Pediatric wide-field fundus photograph: 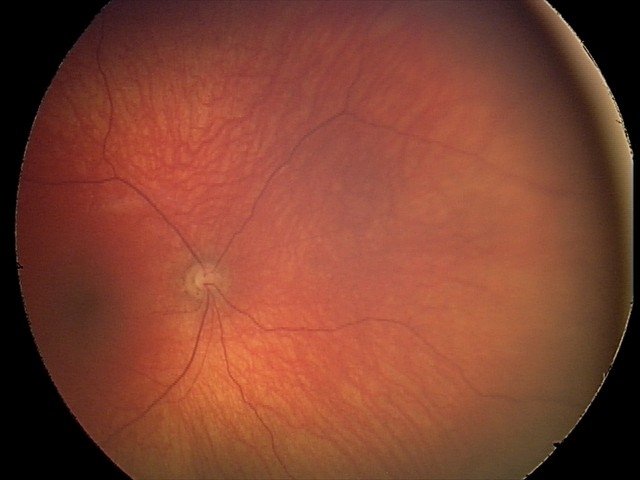 Finding: optic nerve hypoplasia.